Infant wide-field fundus photograph; 1240 x 1240 pixels; acquired on the Phoenix ICON — 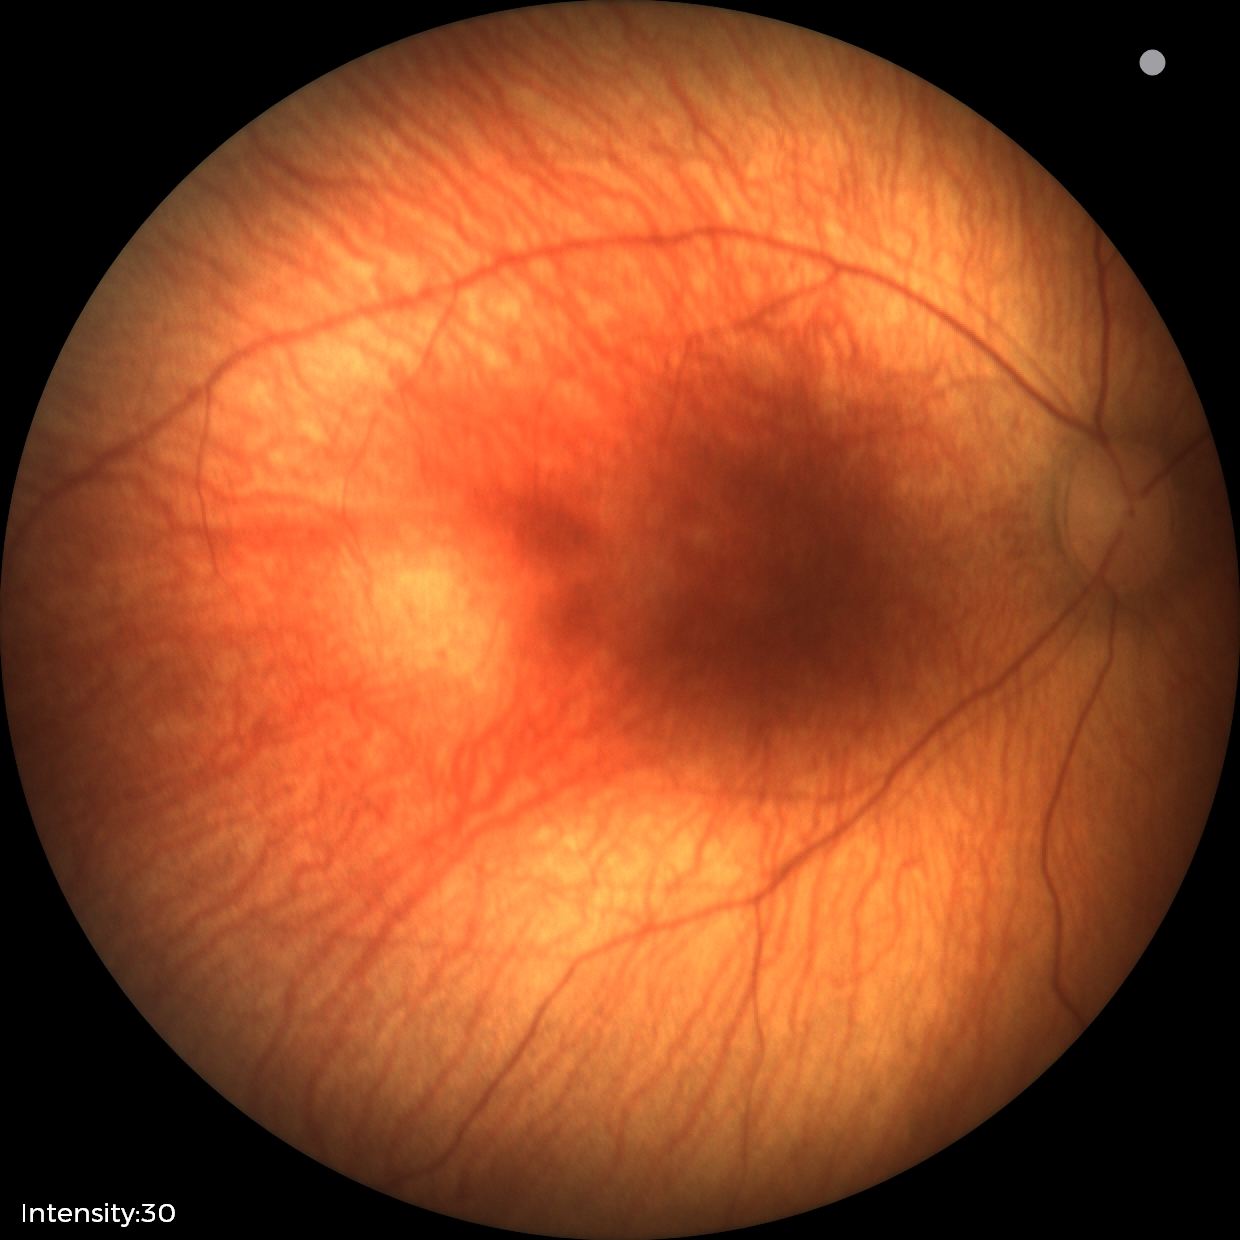
Examination with physiological retinal findings.